DR severity per modified Davis staging; without pupil dilation; image size 848x848; 45° FOV; posterior pole color fundus photograph — 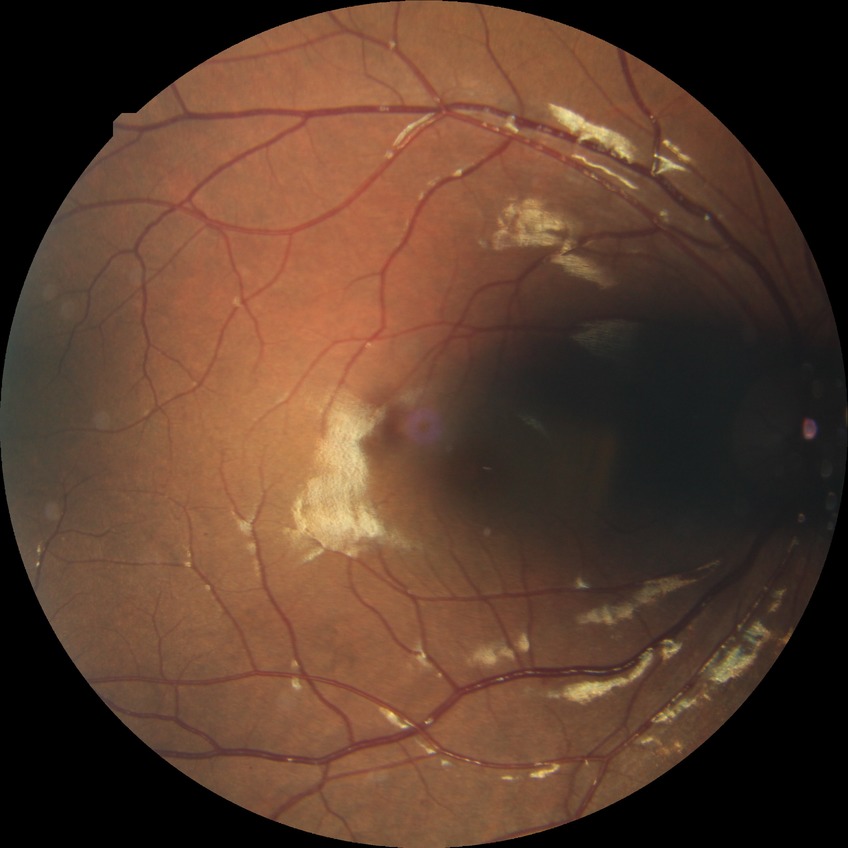 Annotations:
- DR stage — SDR